Captured on a Remidio Fundus on Phone (FOP) camera.
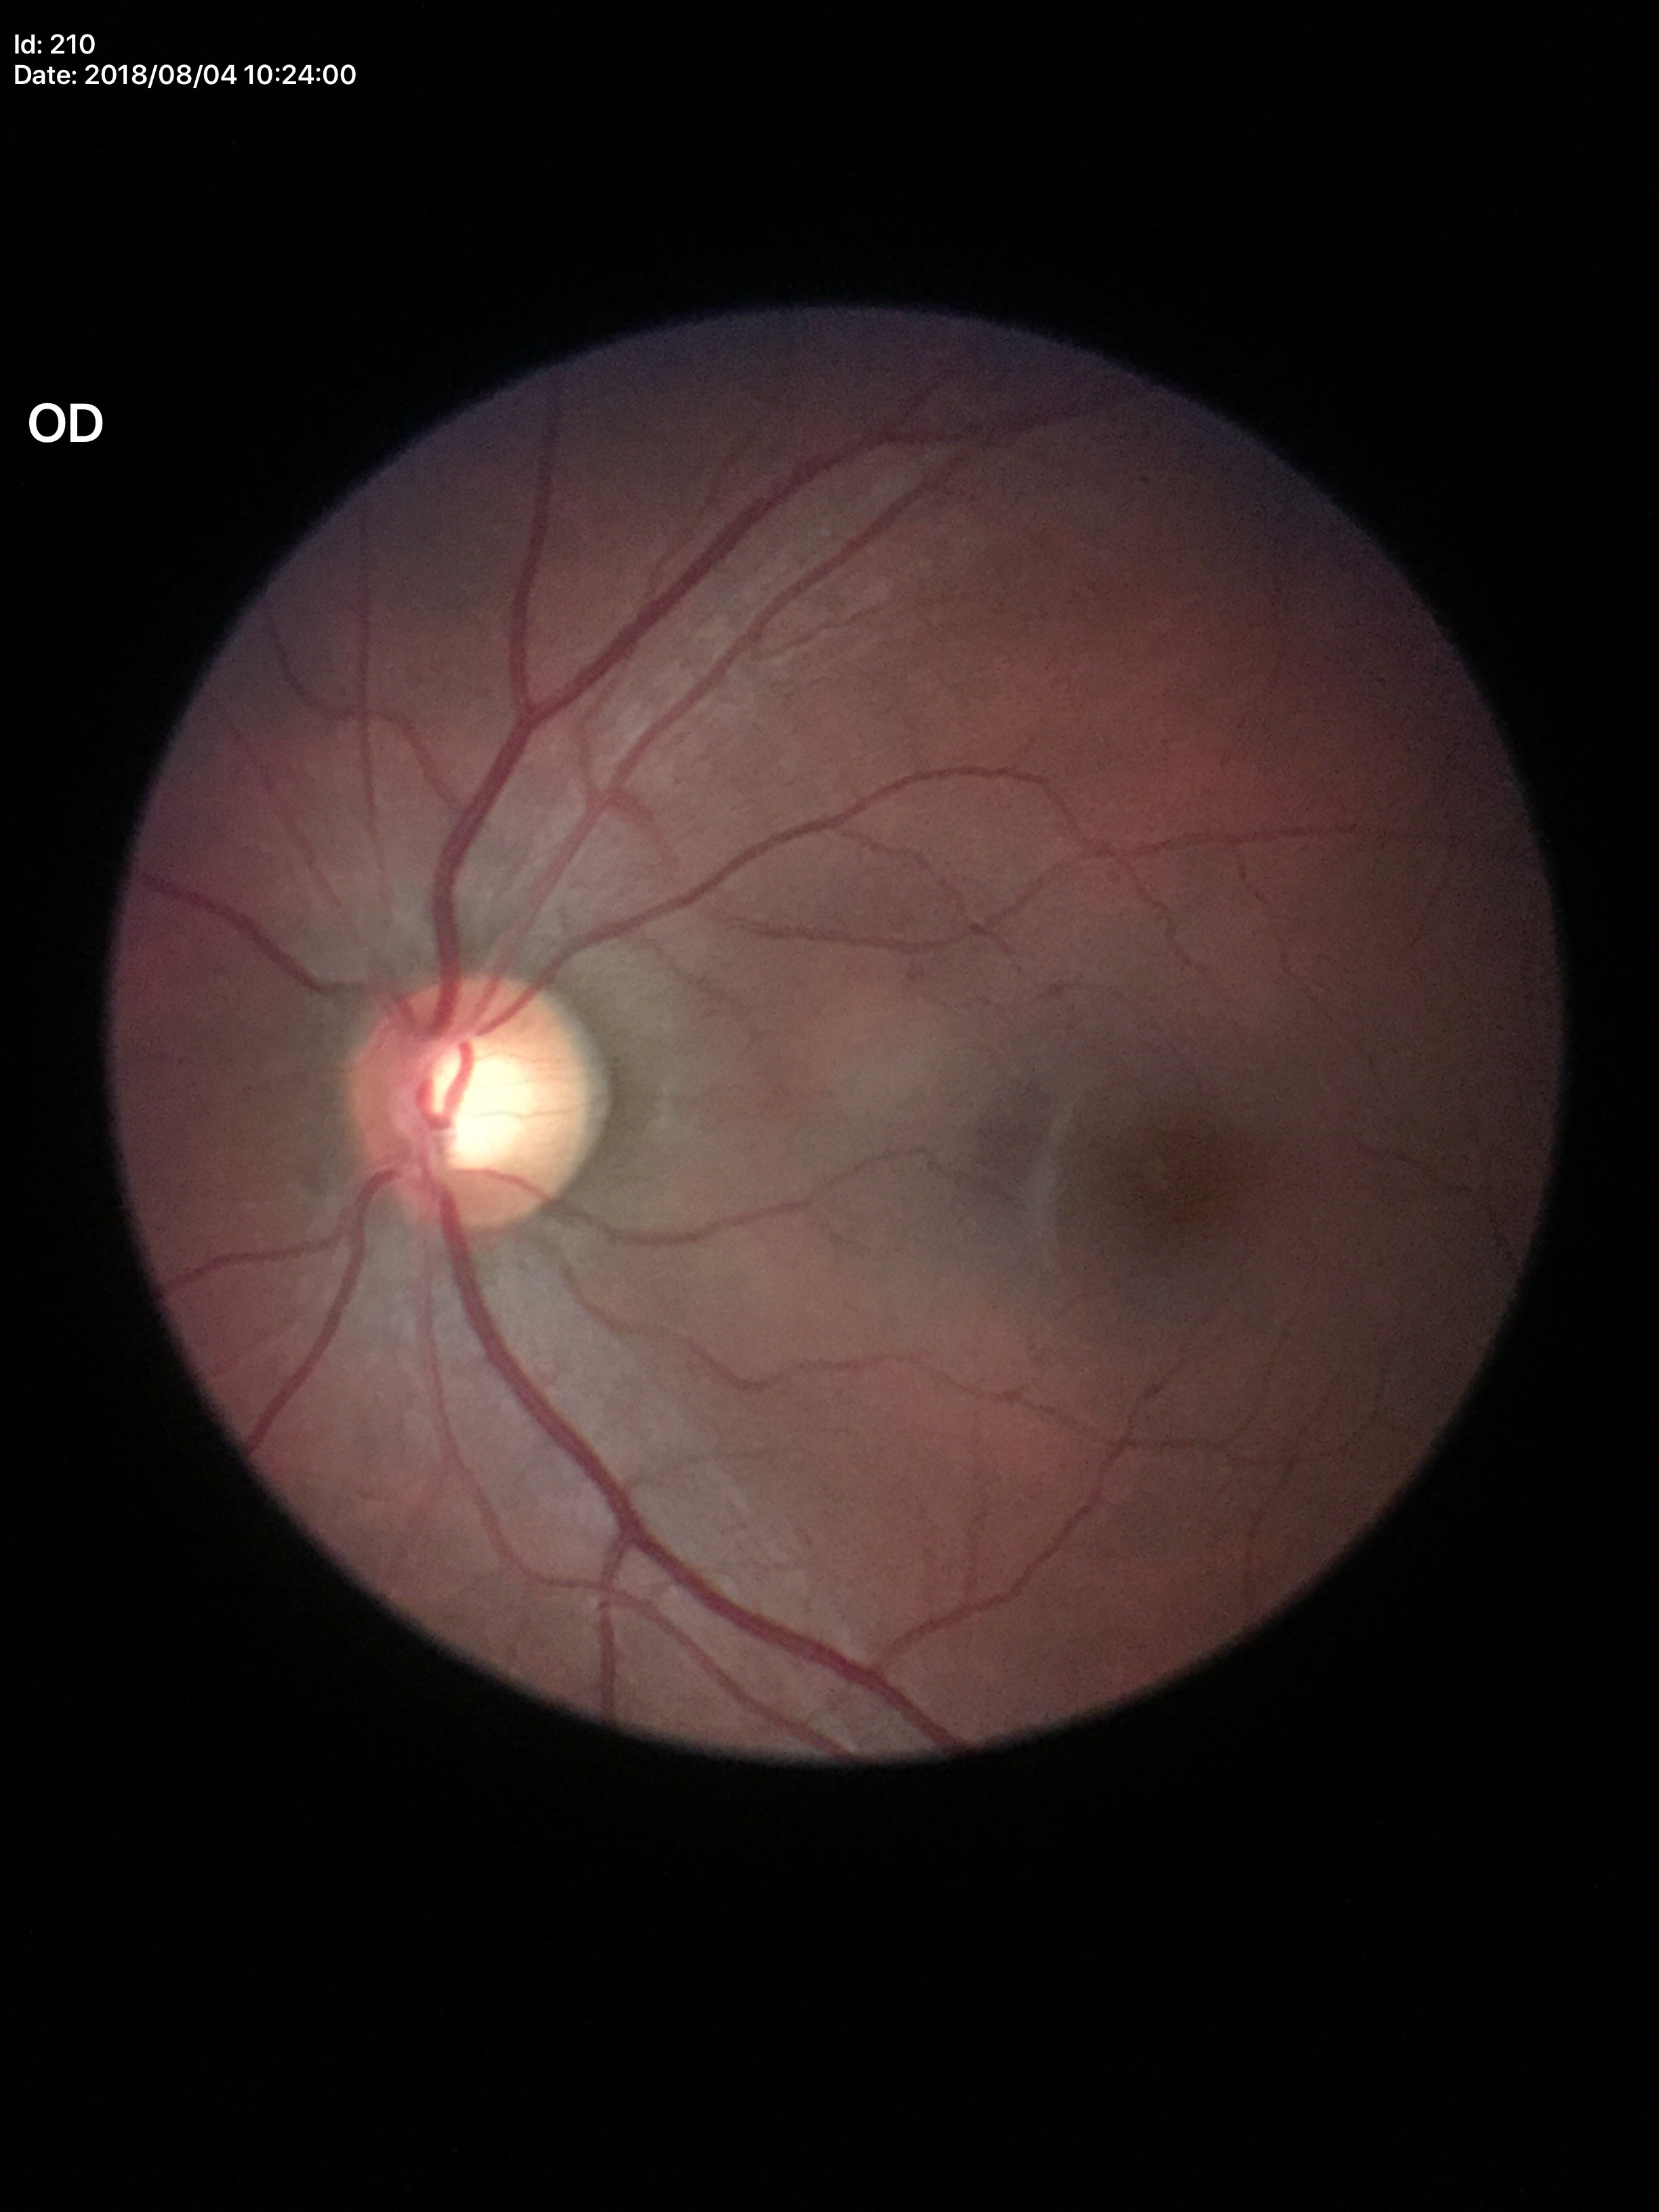 vertical CDR (VCDR)=0.58 | Glaucoma screening impression=not suspect (1 of 5 graders flagged glaucoma suspect) | horizontal CDR (HCDR)=0.58